Optic nerve head crop. Fundus photo: 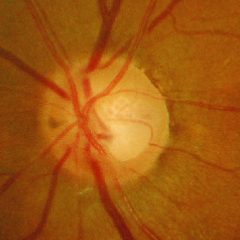 Findings consistent with glaucoma. Demonstrates severe glaucomatous damage.